45-degree field of view, nonmydriatic, acquired with a NIDEK AFC-230, 848 by 848 pixels
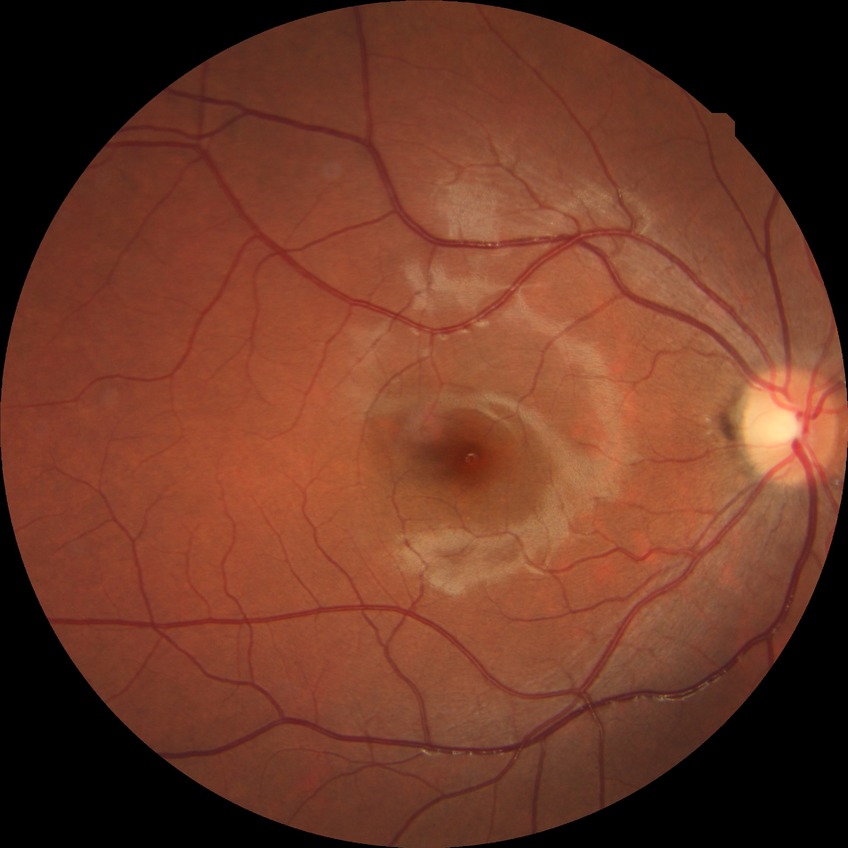

Diabetic retinopathy (DR): NDR (no diabetic retinopathy).